Phoenix ICON, 100° FOV · wide-field fundus image from infant ROP screening · 1240 by 1240 pixels.
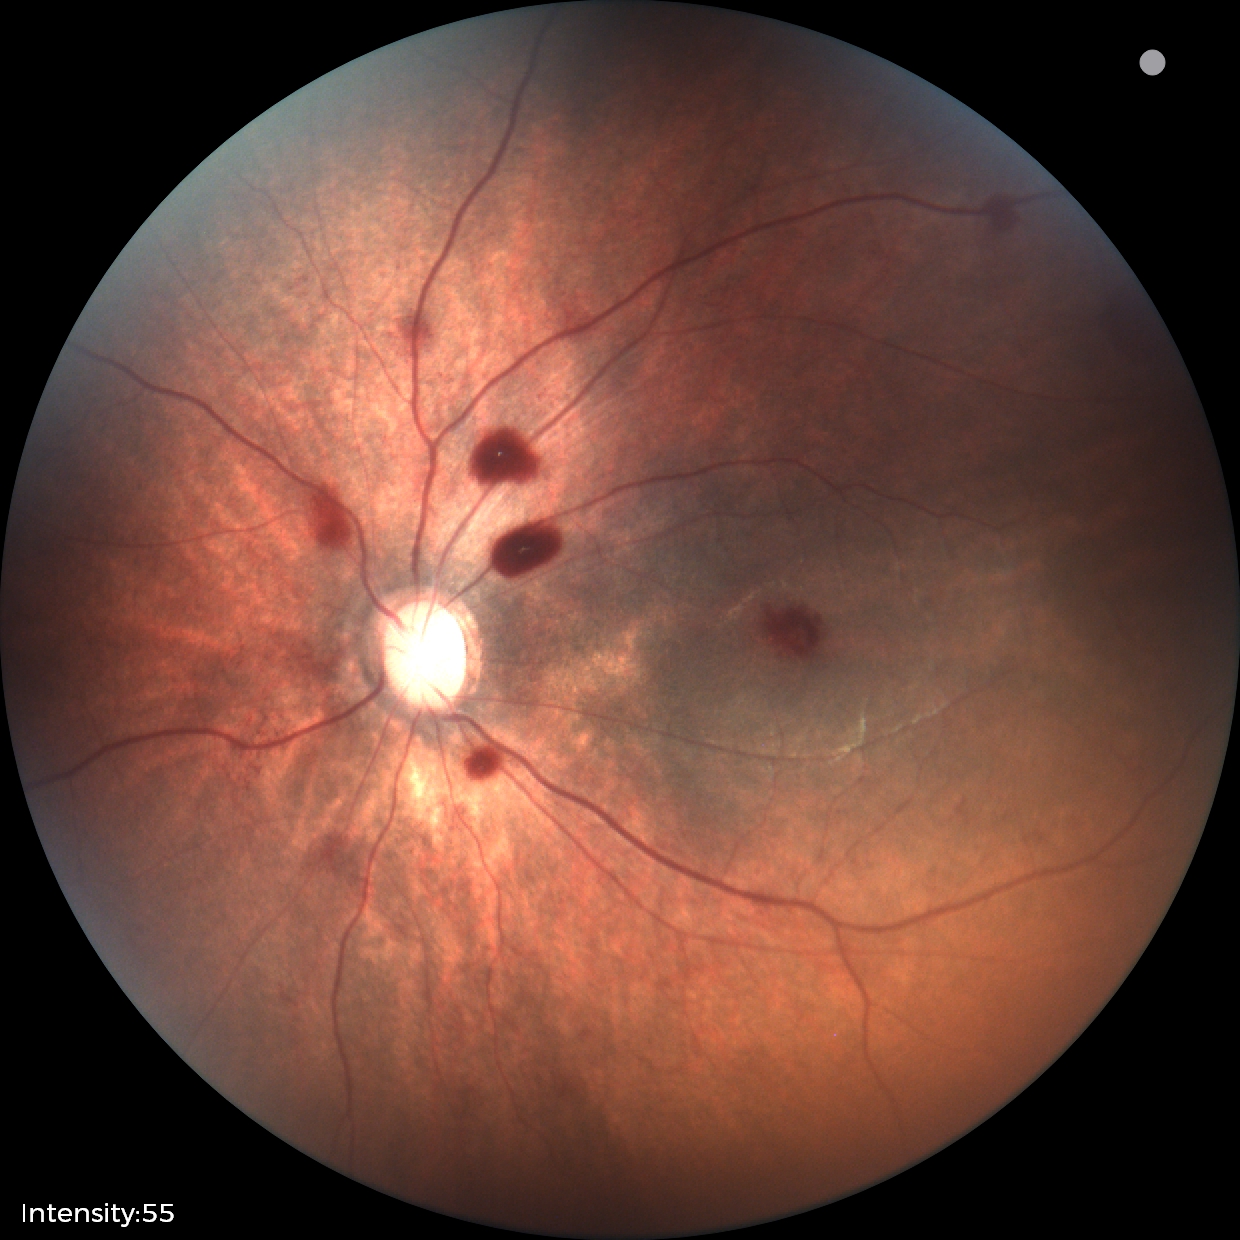

Assessment = retinal hemorrhages.